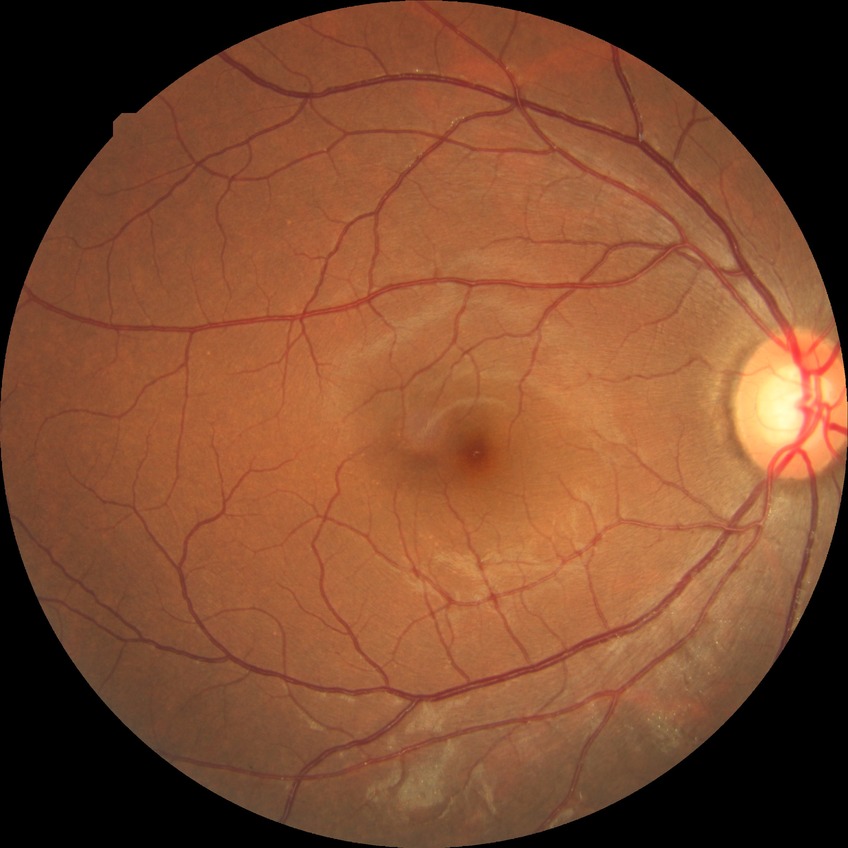
davis_grade: NDR
dr_impression: no signs of DR